45-degree field of view — 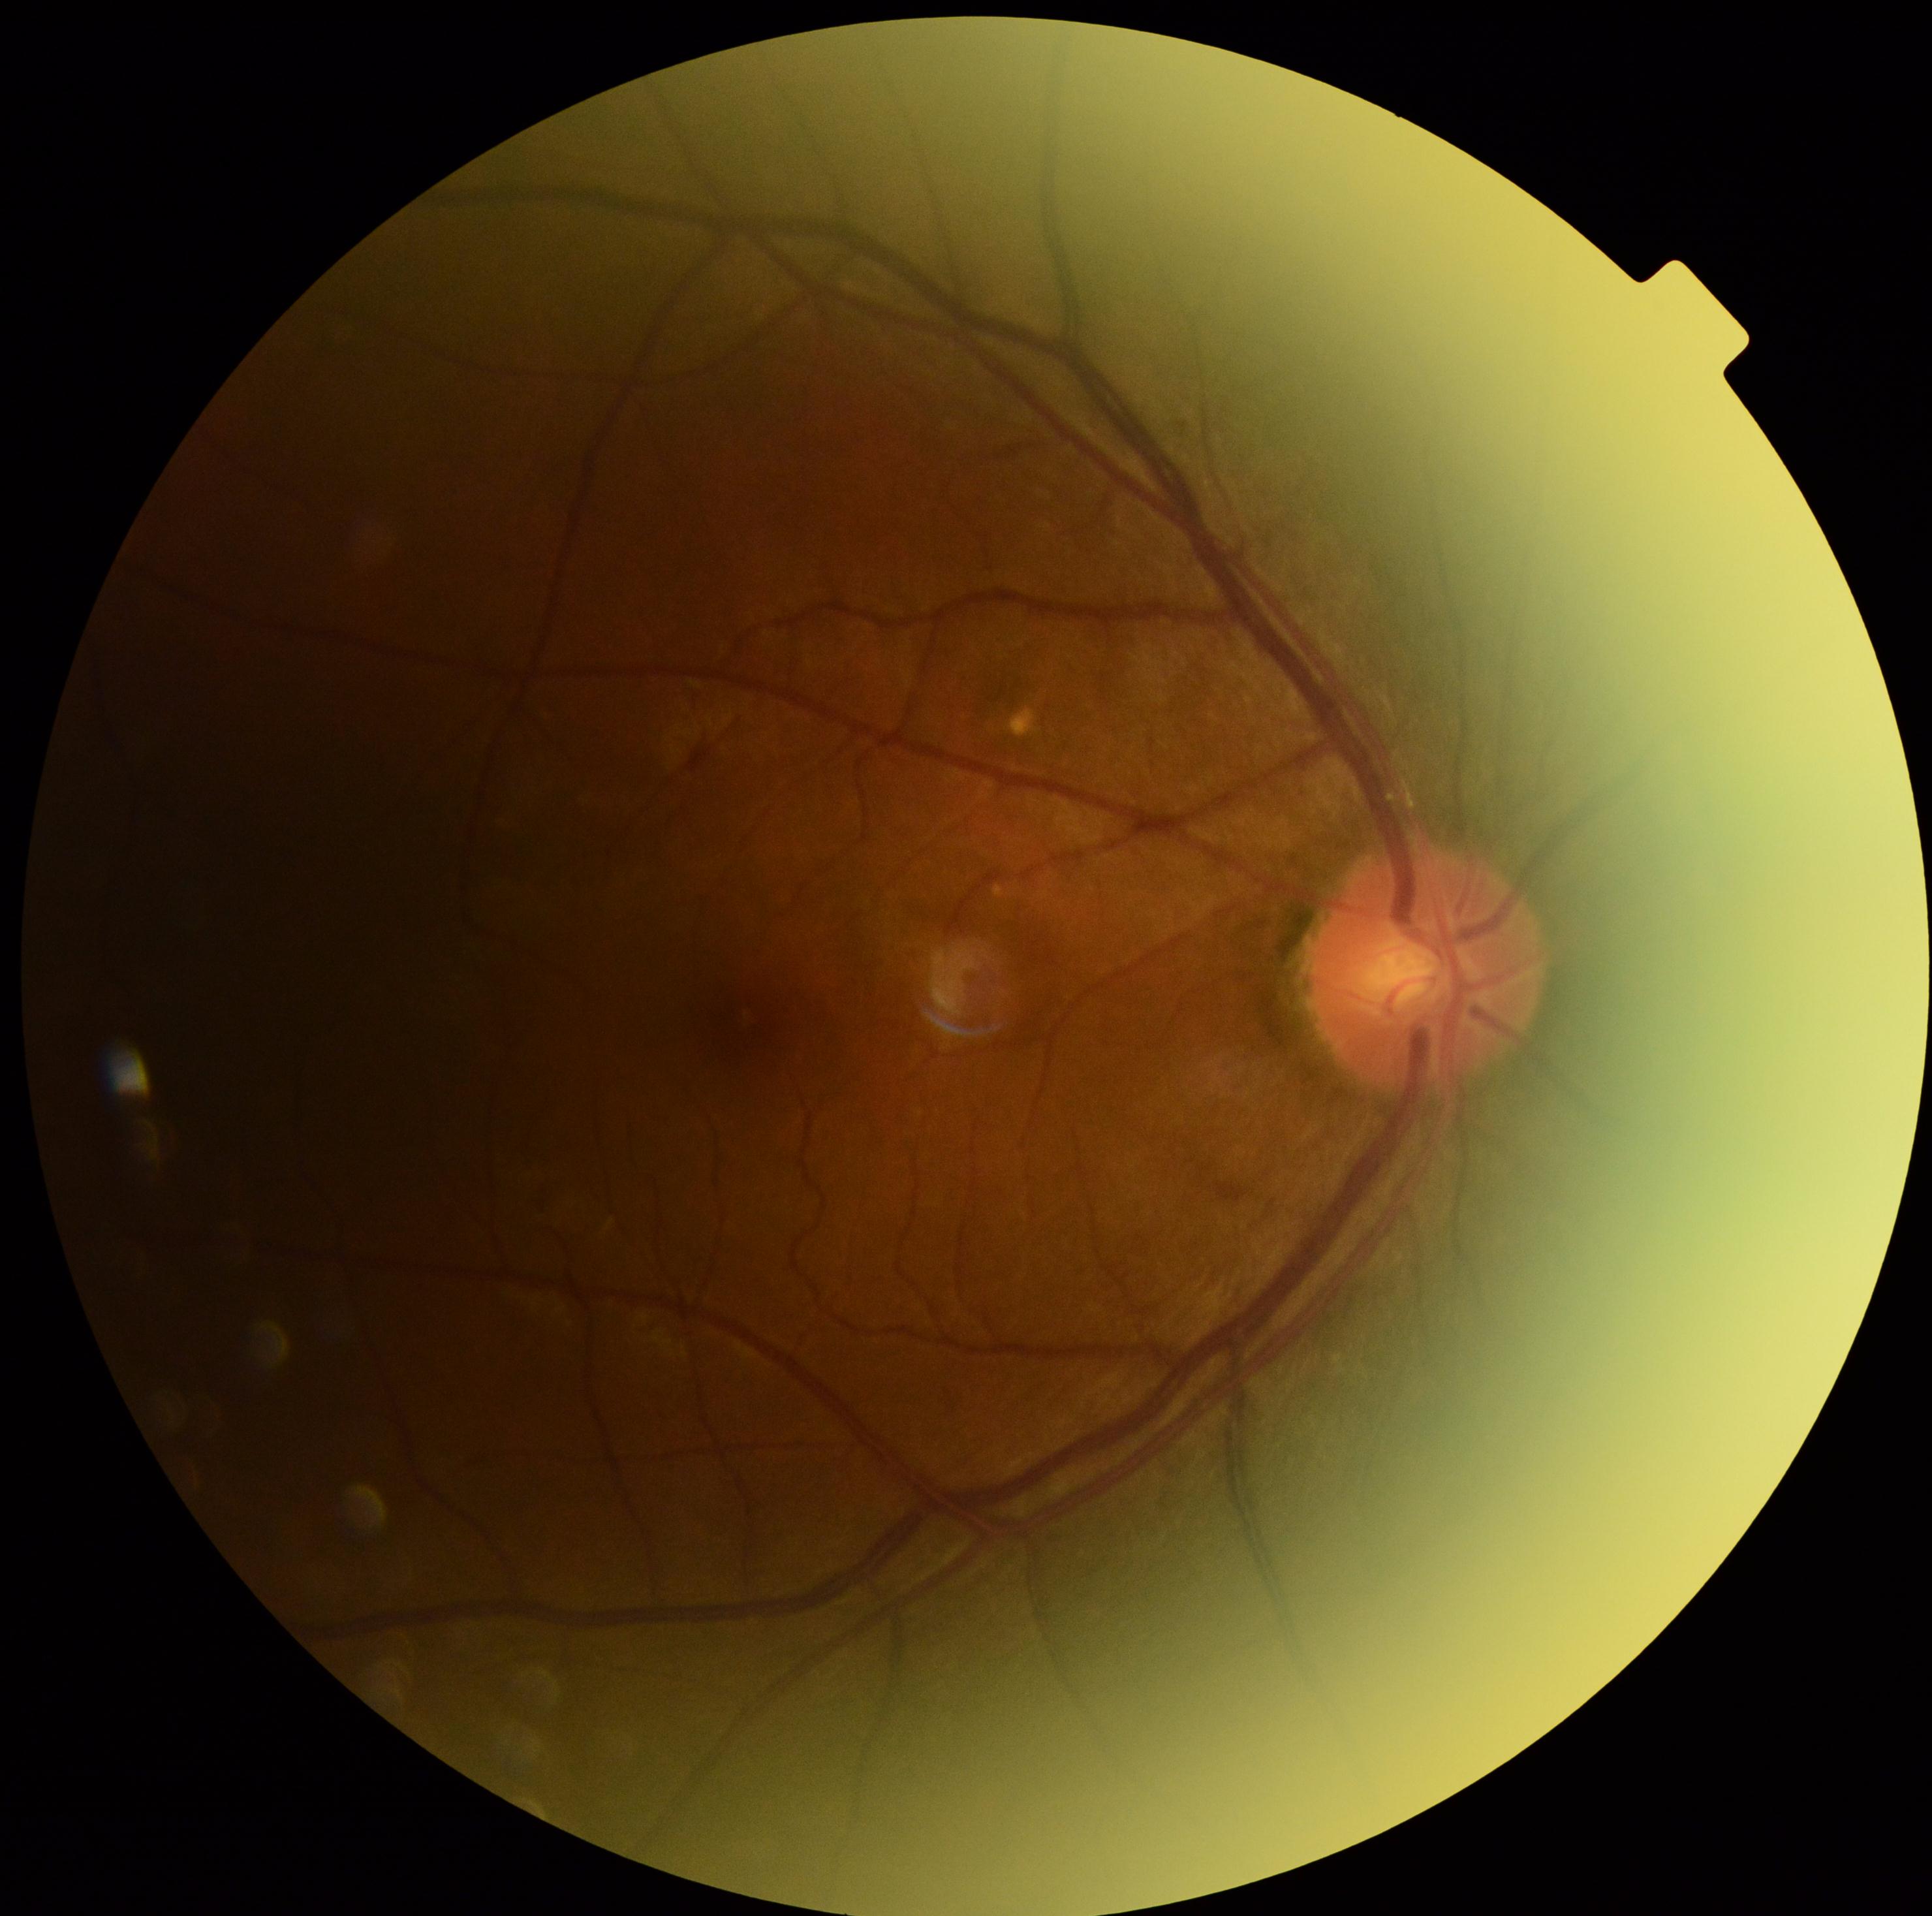

Diabetic retinopathy (DR) is grade 2 (moderate NPDR).